1240 by 1240 pixels; wide-field fundus photograph from neonatal ROP screening; camera: Phoenix ICON (100° FOV): 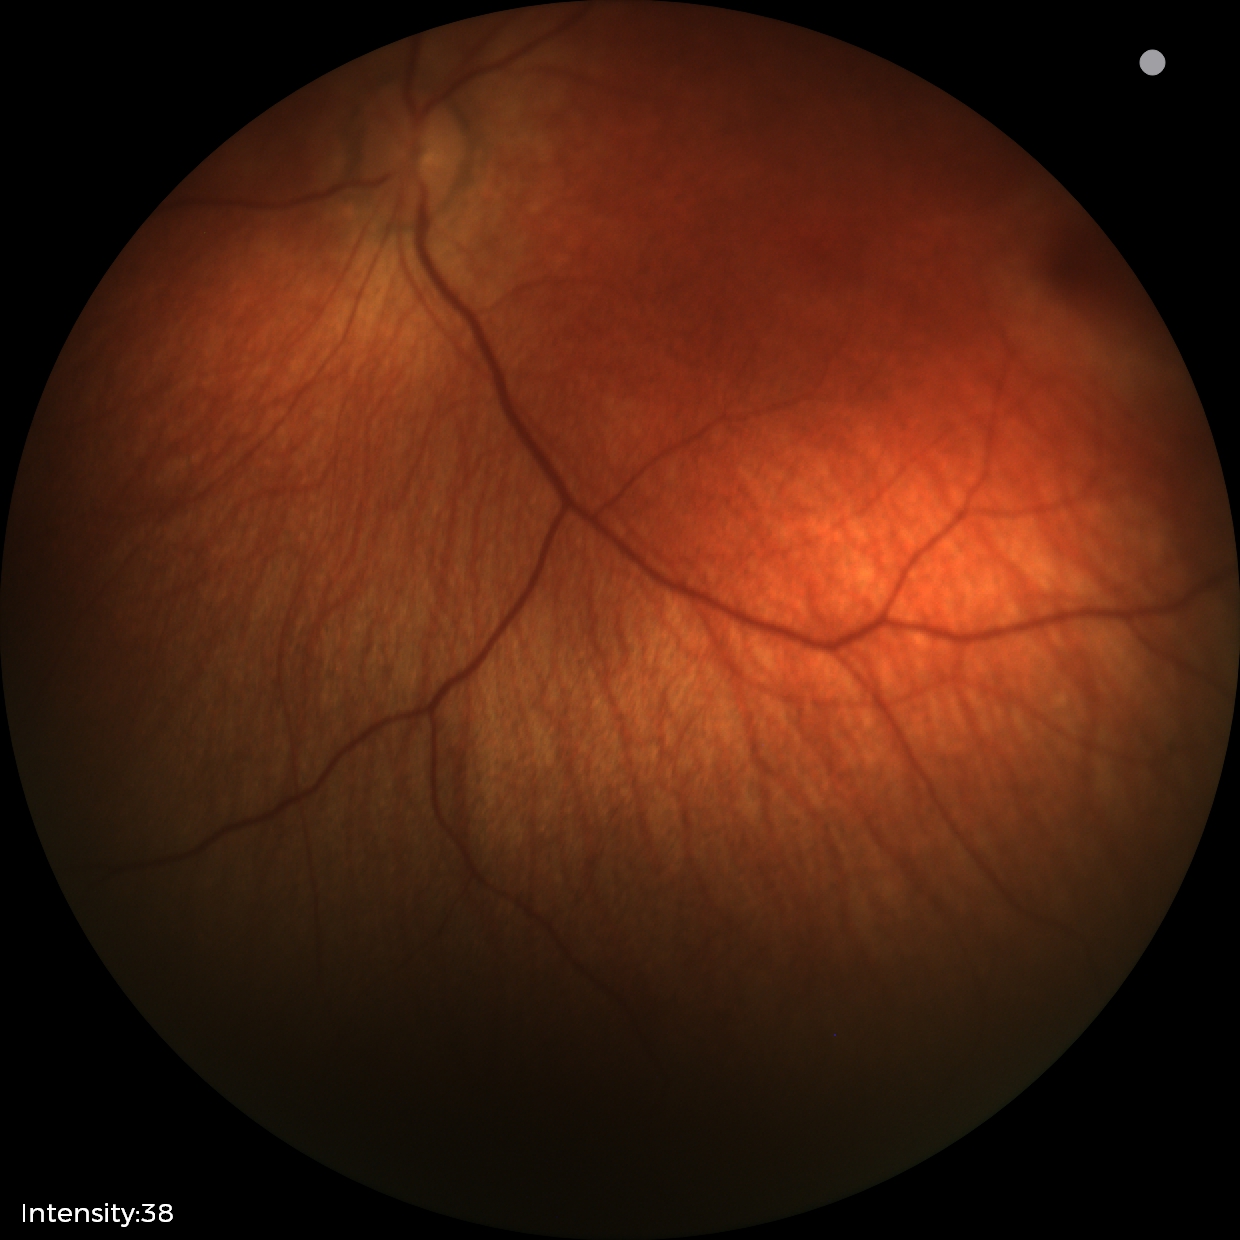

Finding: no pathology identified.